100° field of view (Phoenix ICON) · pediatric wide-field fundus photograph · 1240 x 1240 pixels.
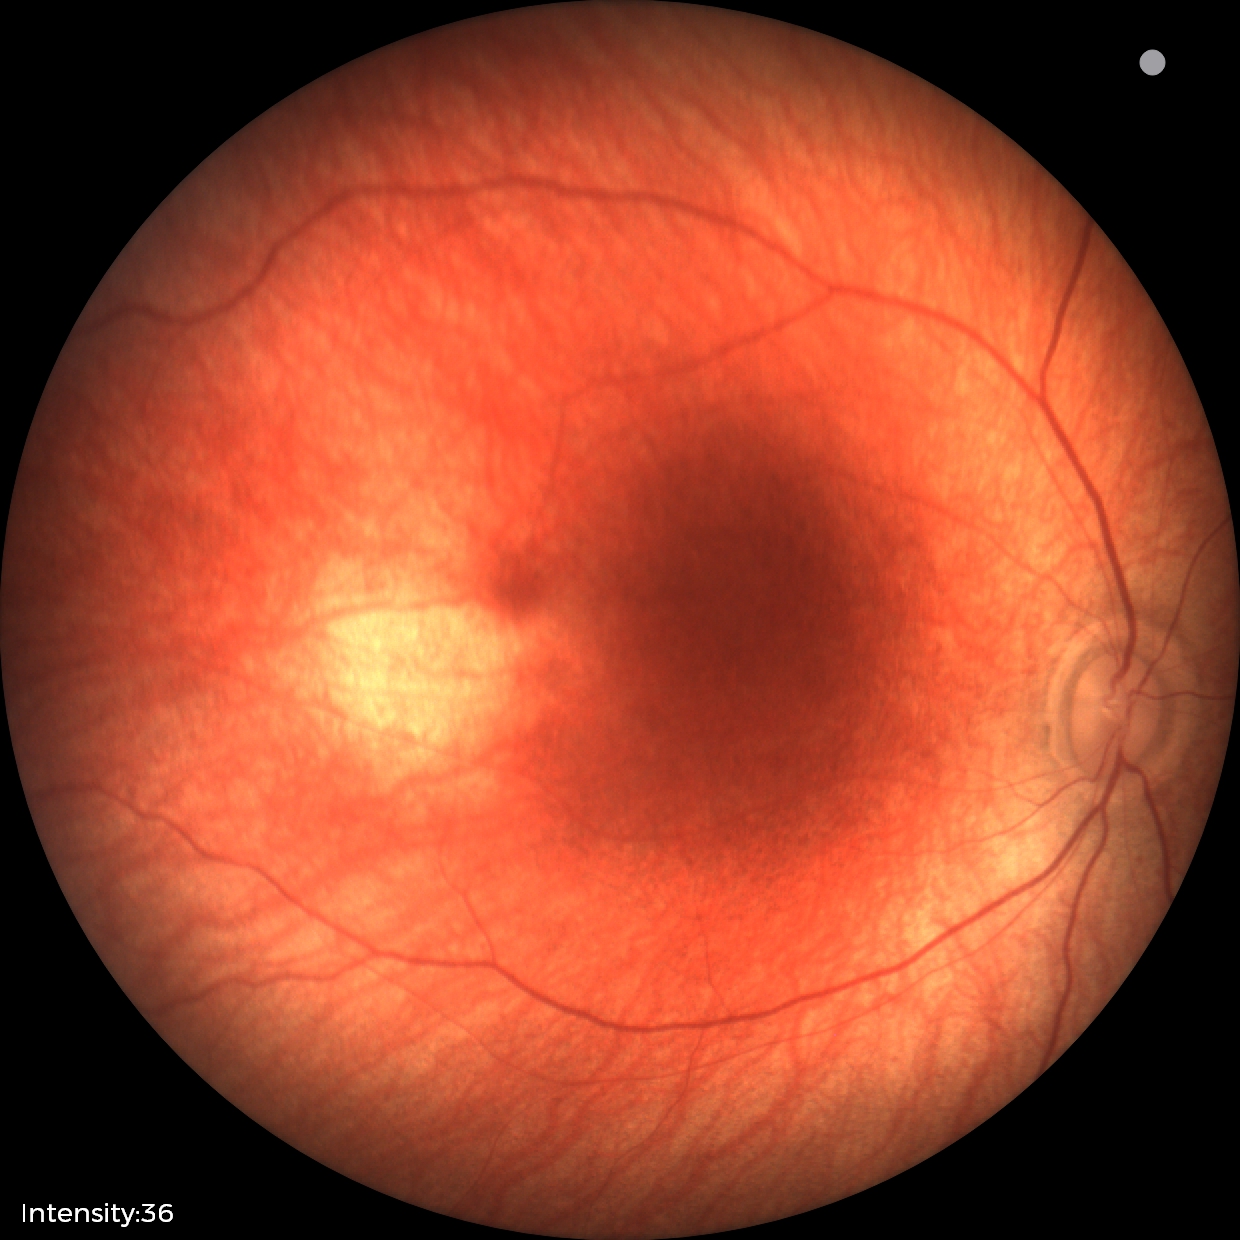

Q: What is the screening diagnosis?
A: physiological finding